130° field of view (Natus RetCam Envision). RetCam wide-field infant fundus image. 1440 x 1080 pixels — 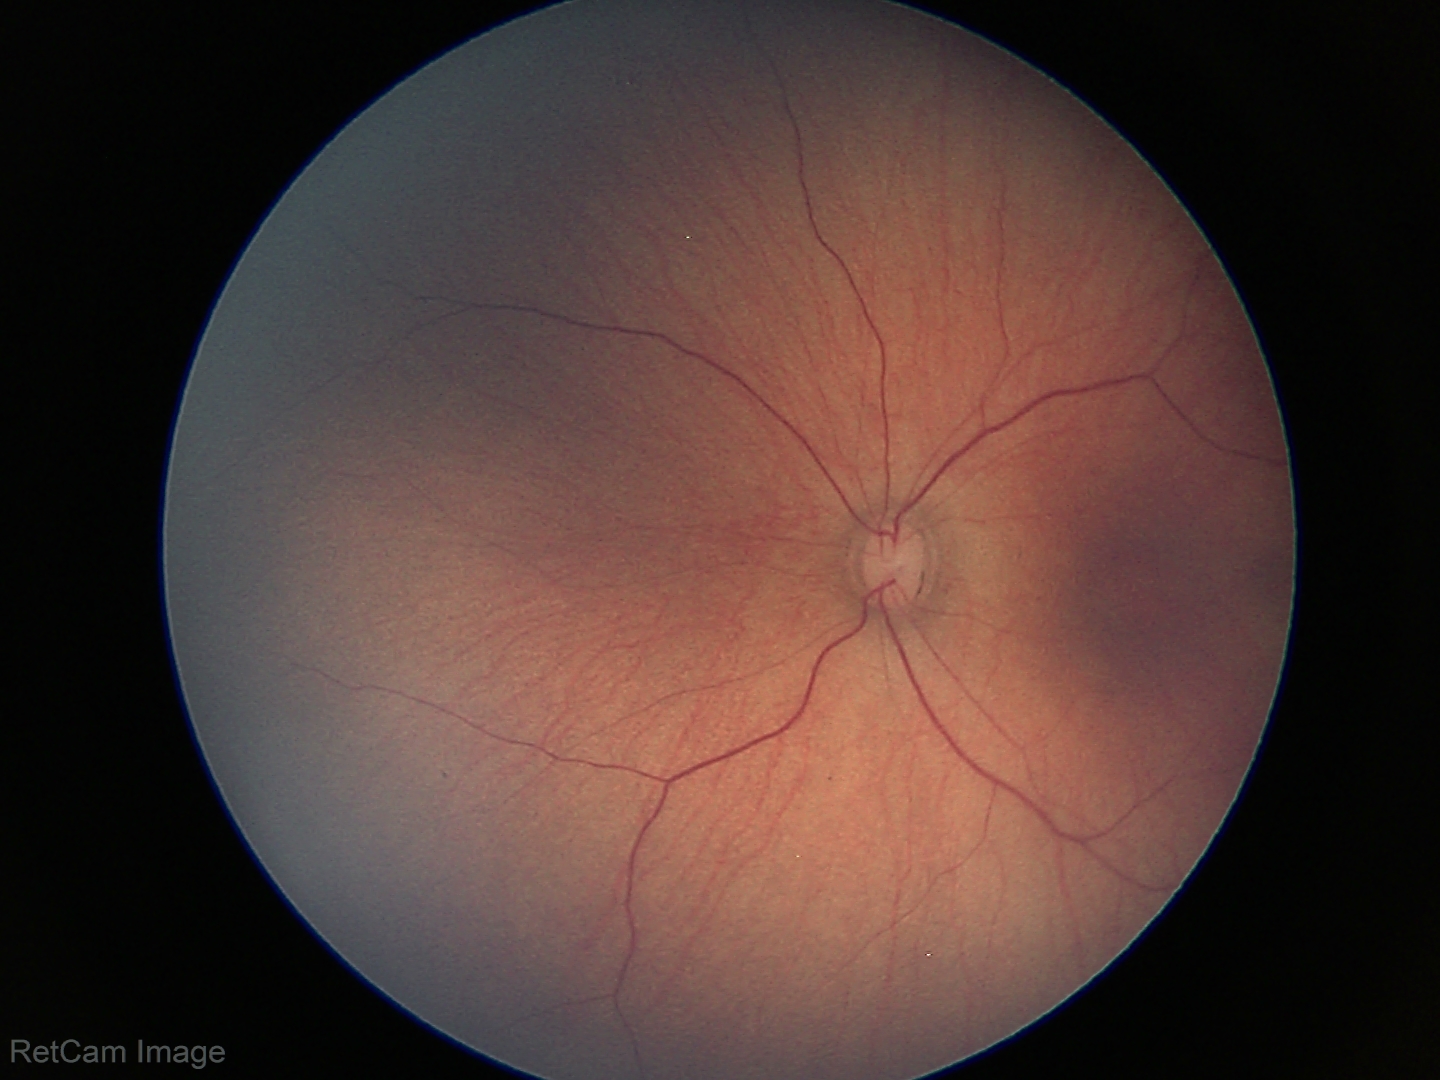
Normal screening examination.